Wide-field fundus photograph from neonatal ROP screening — 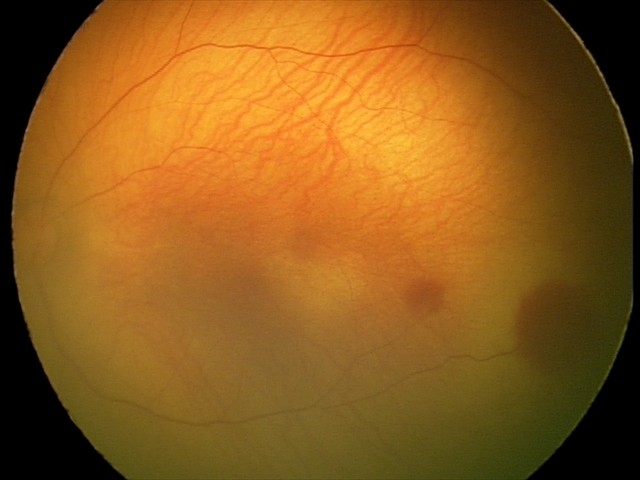

Impression: retinal hemorrhages